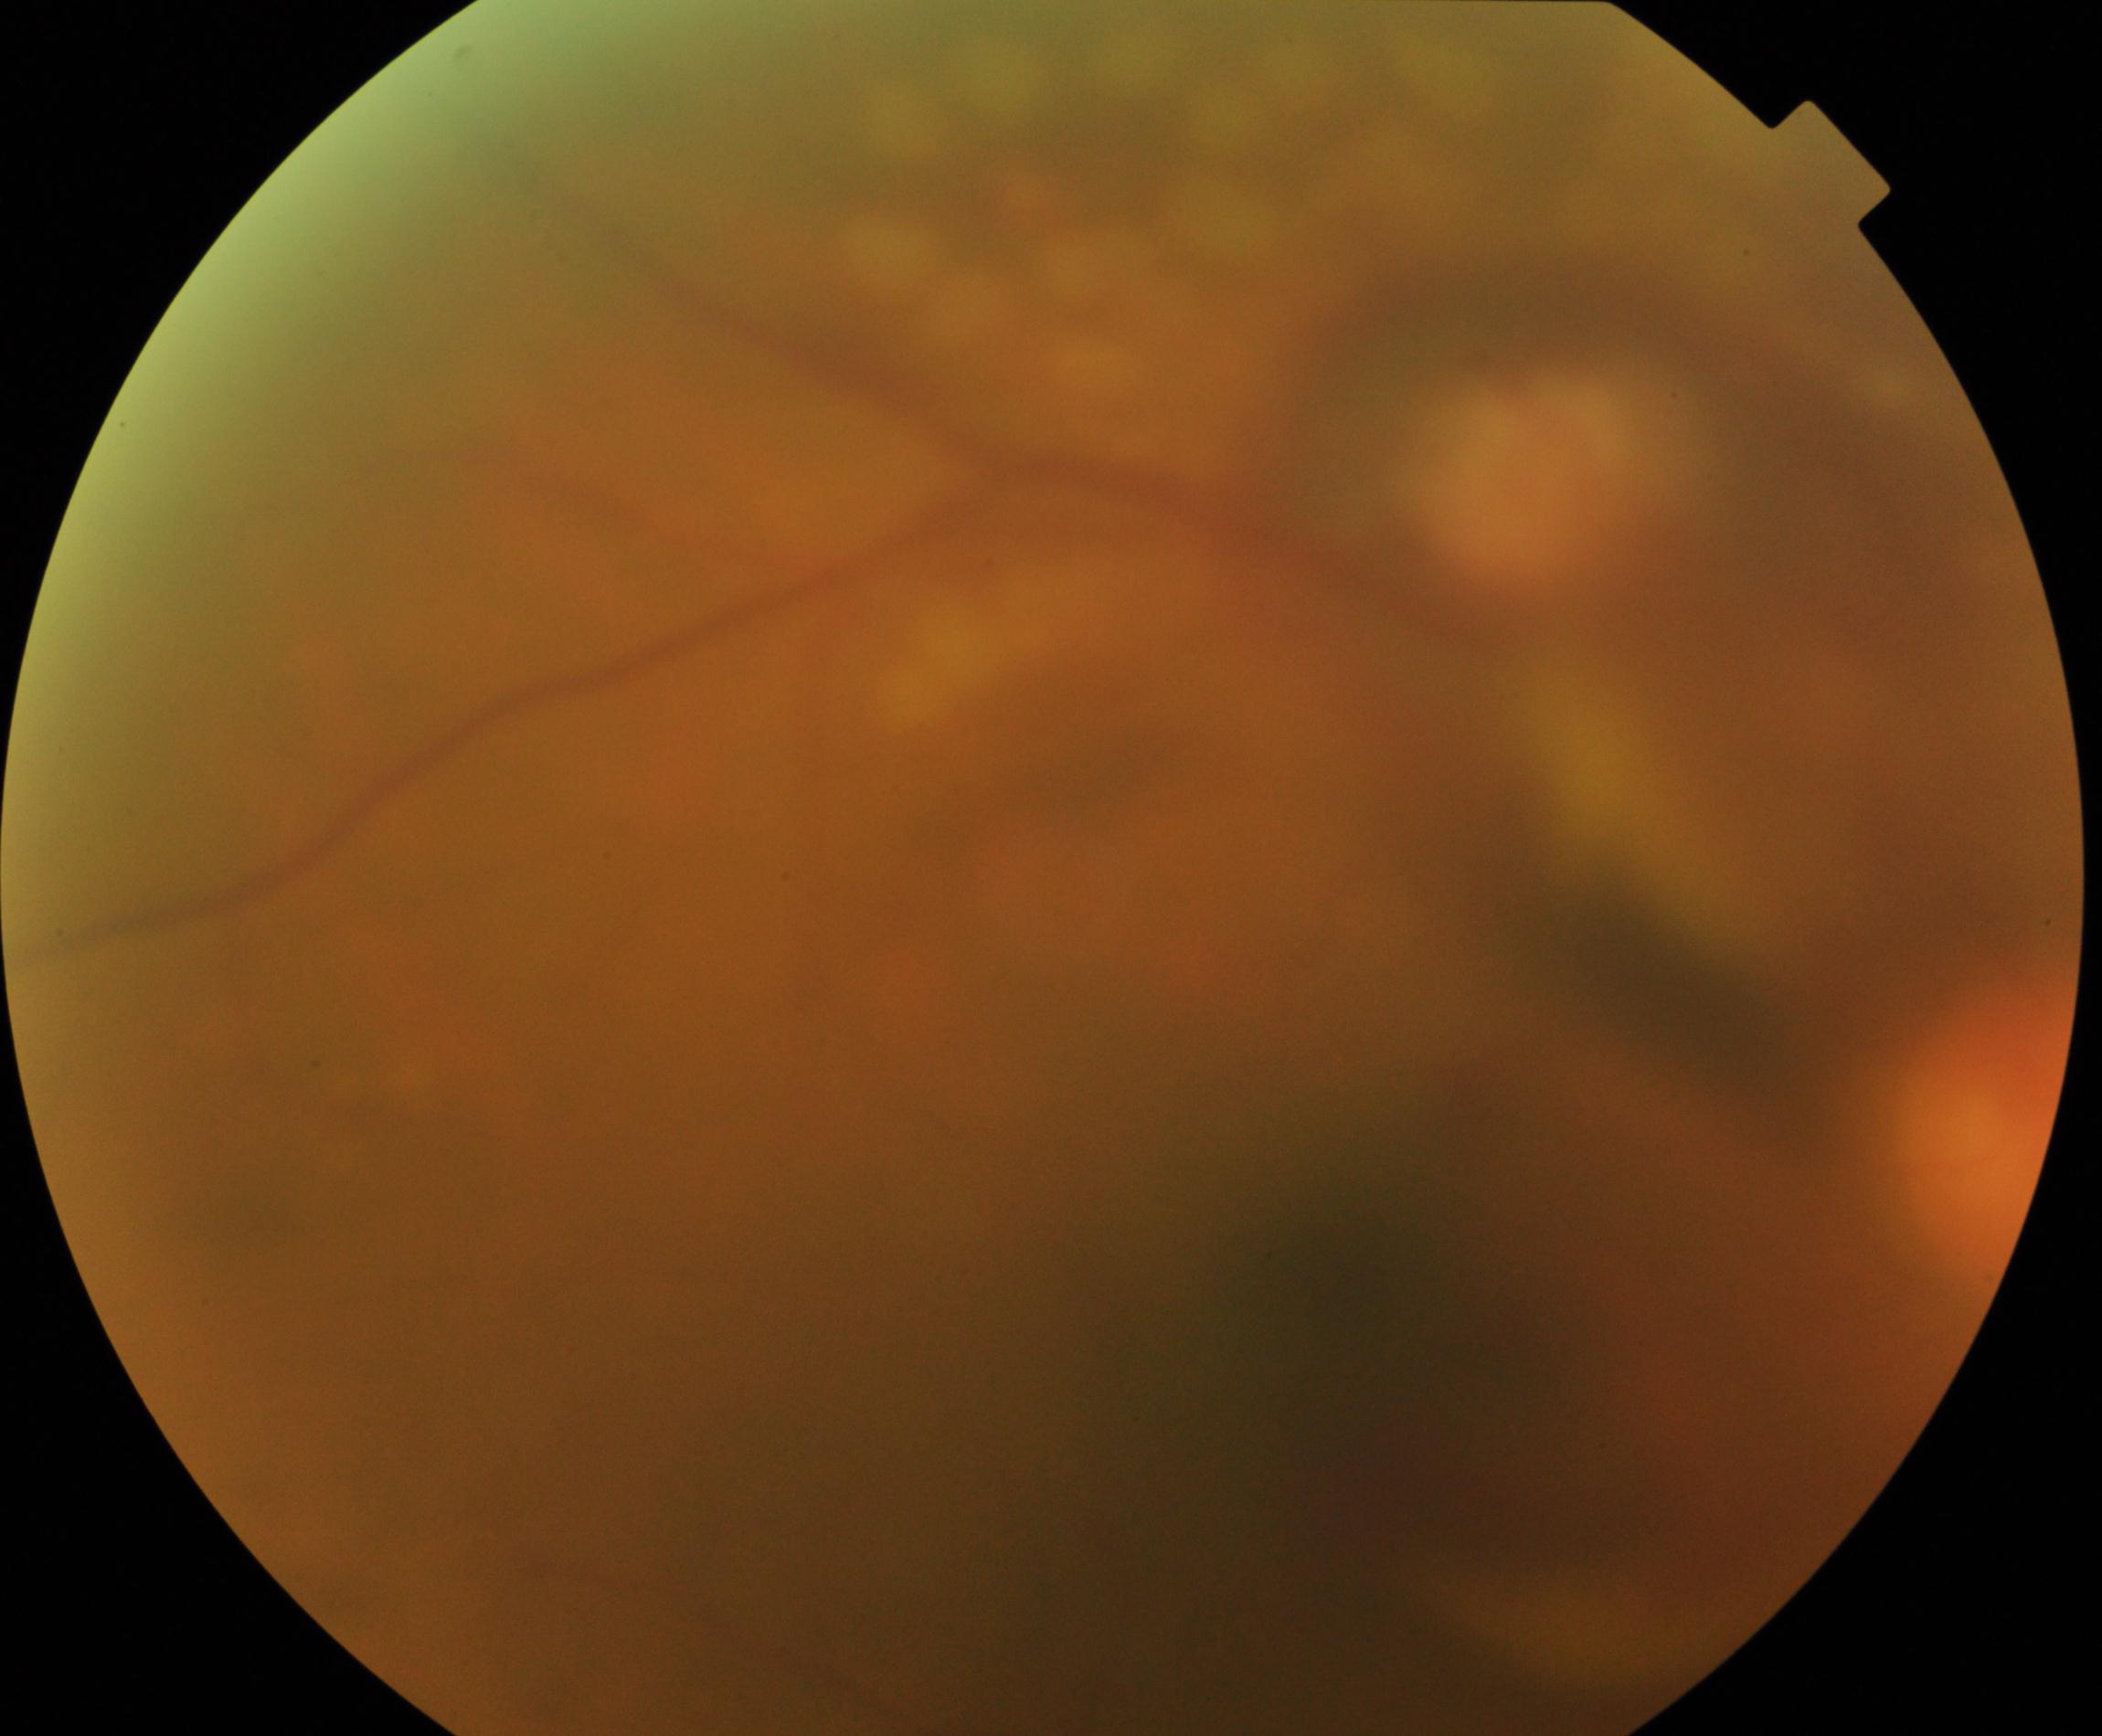
Blurred fundus image with substantial obscuration of retinal landmarks. Proliferative diabetic retinopathy is suspected.